2352x1568px; 45° FOV:
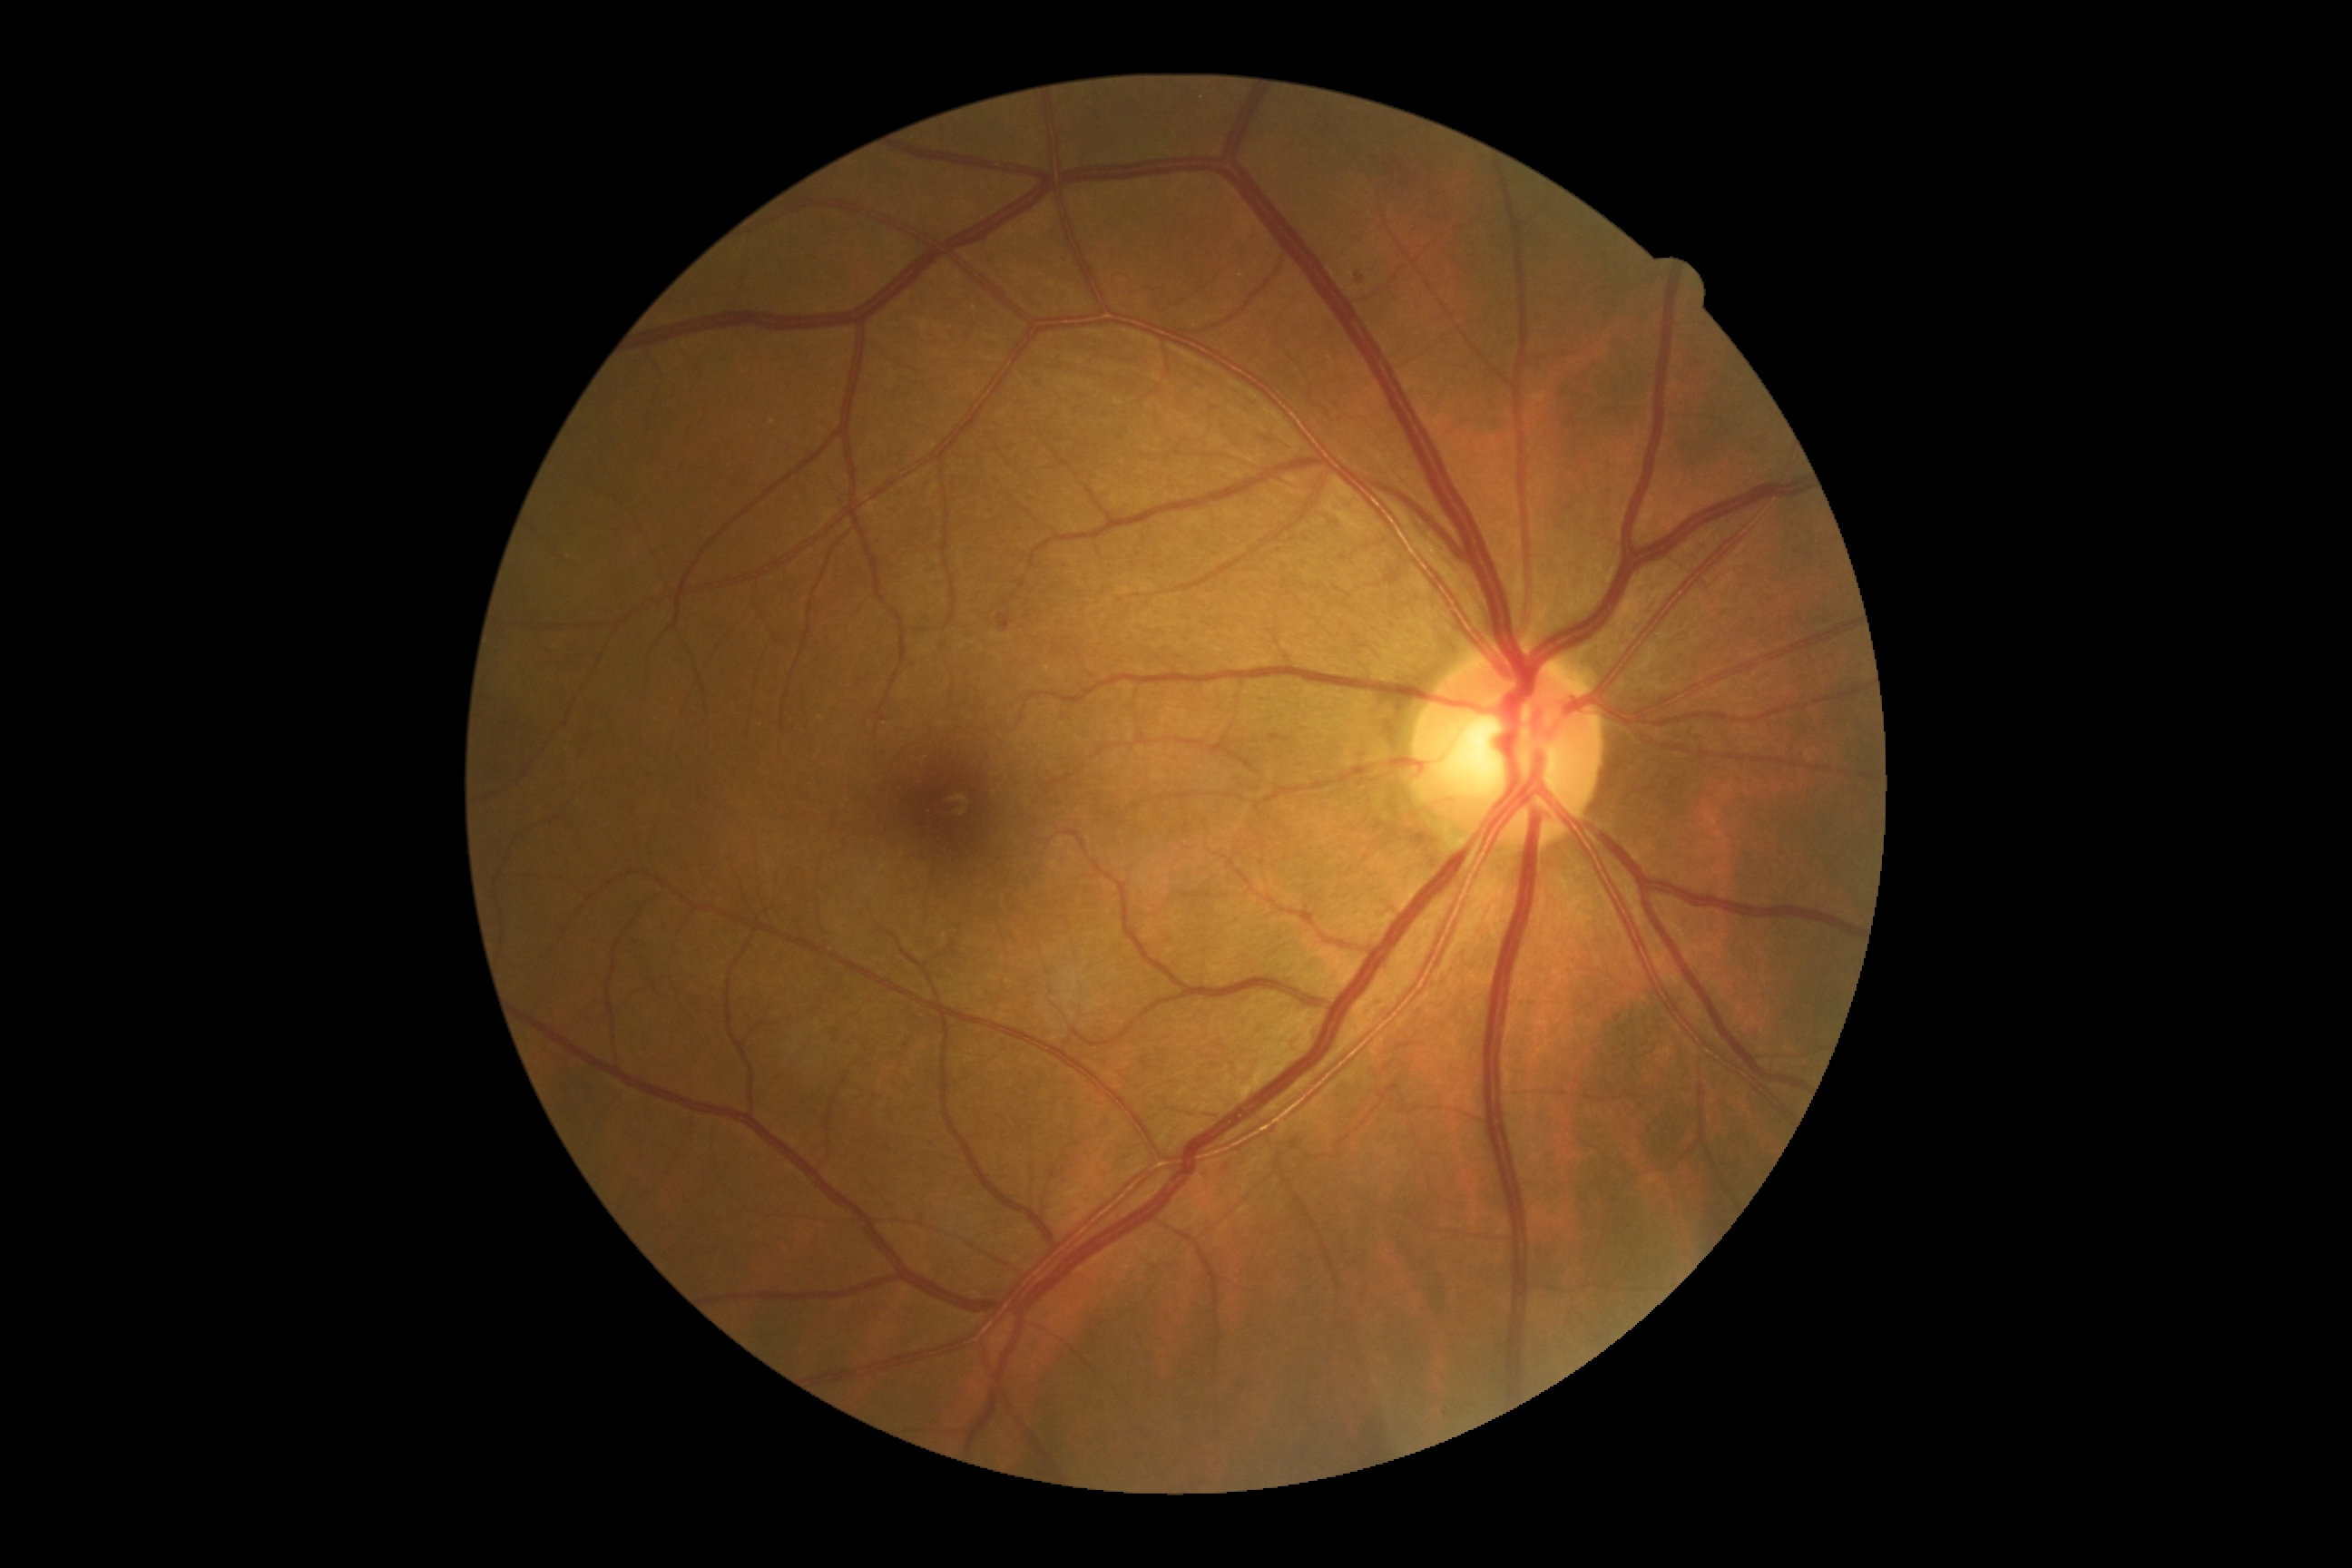

DR = mild non-proliferative diabetic retinopathy (grade 1).